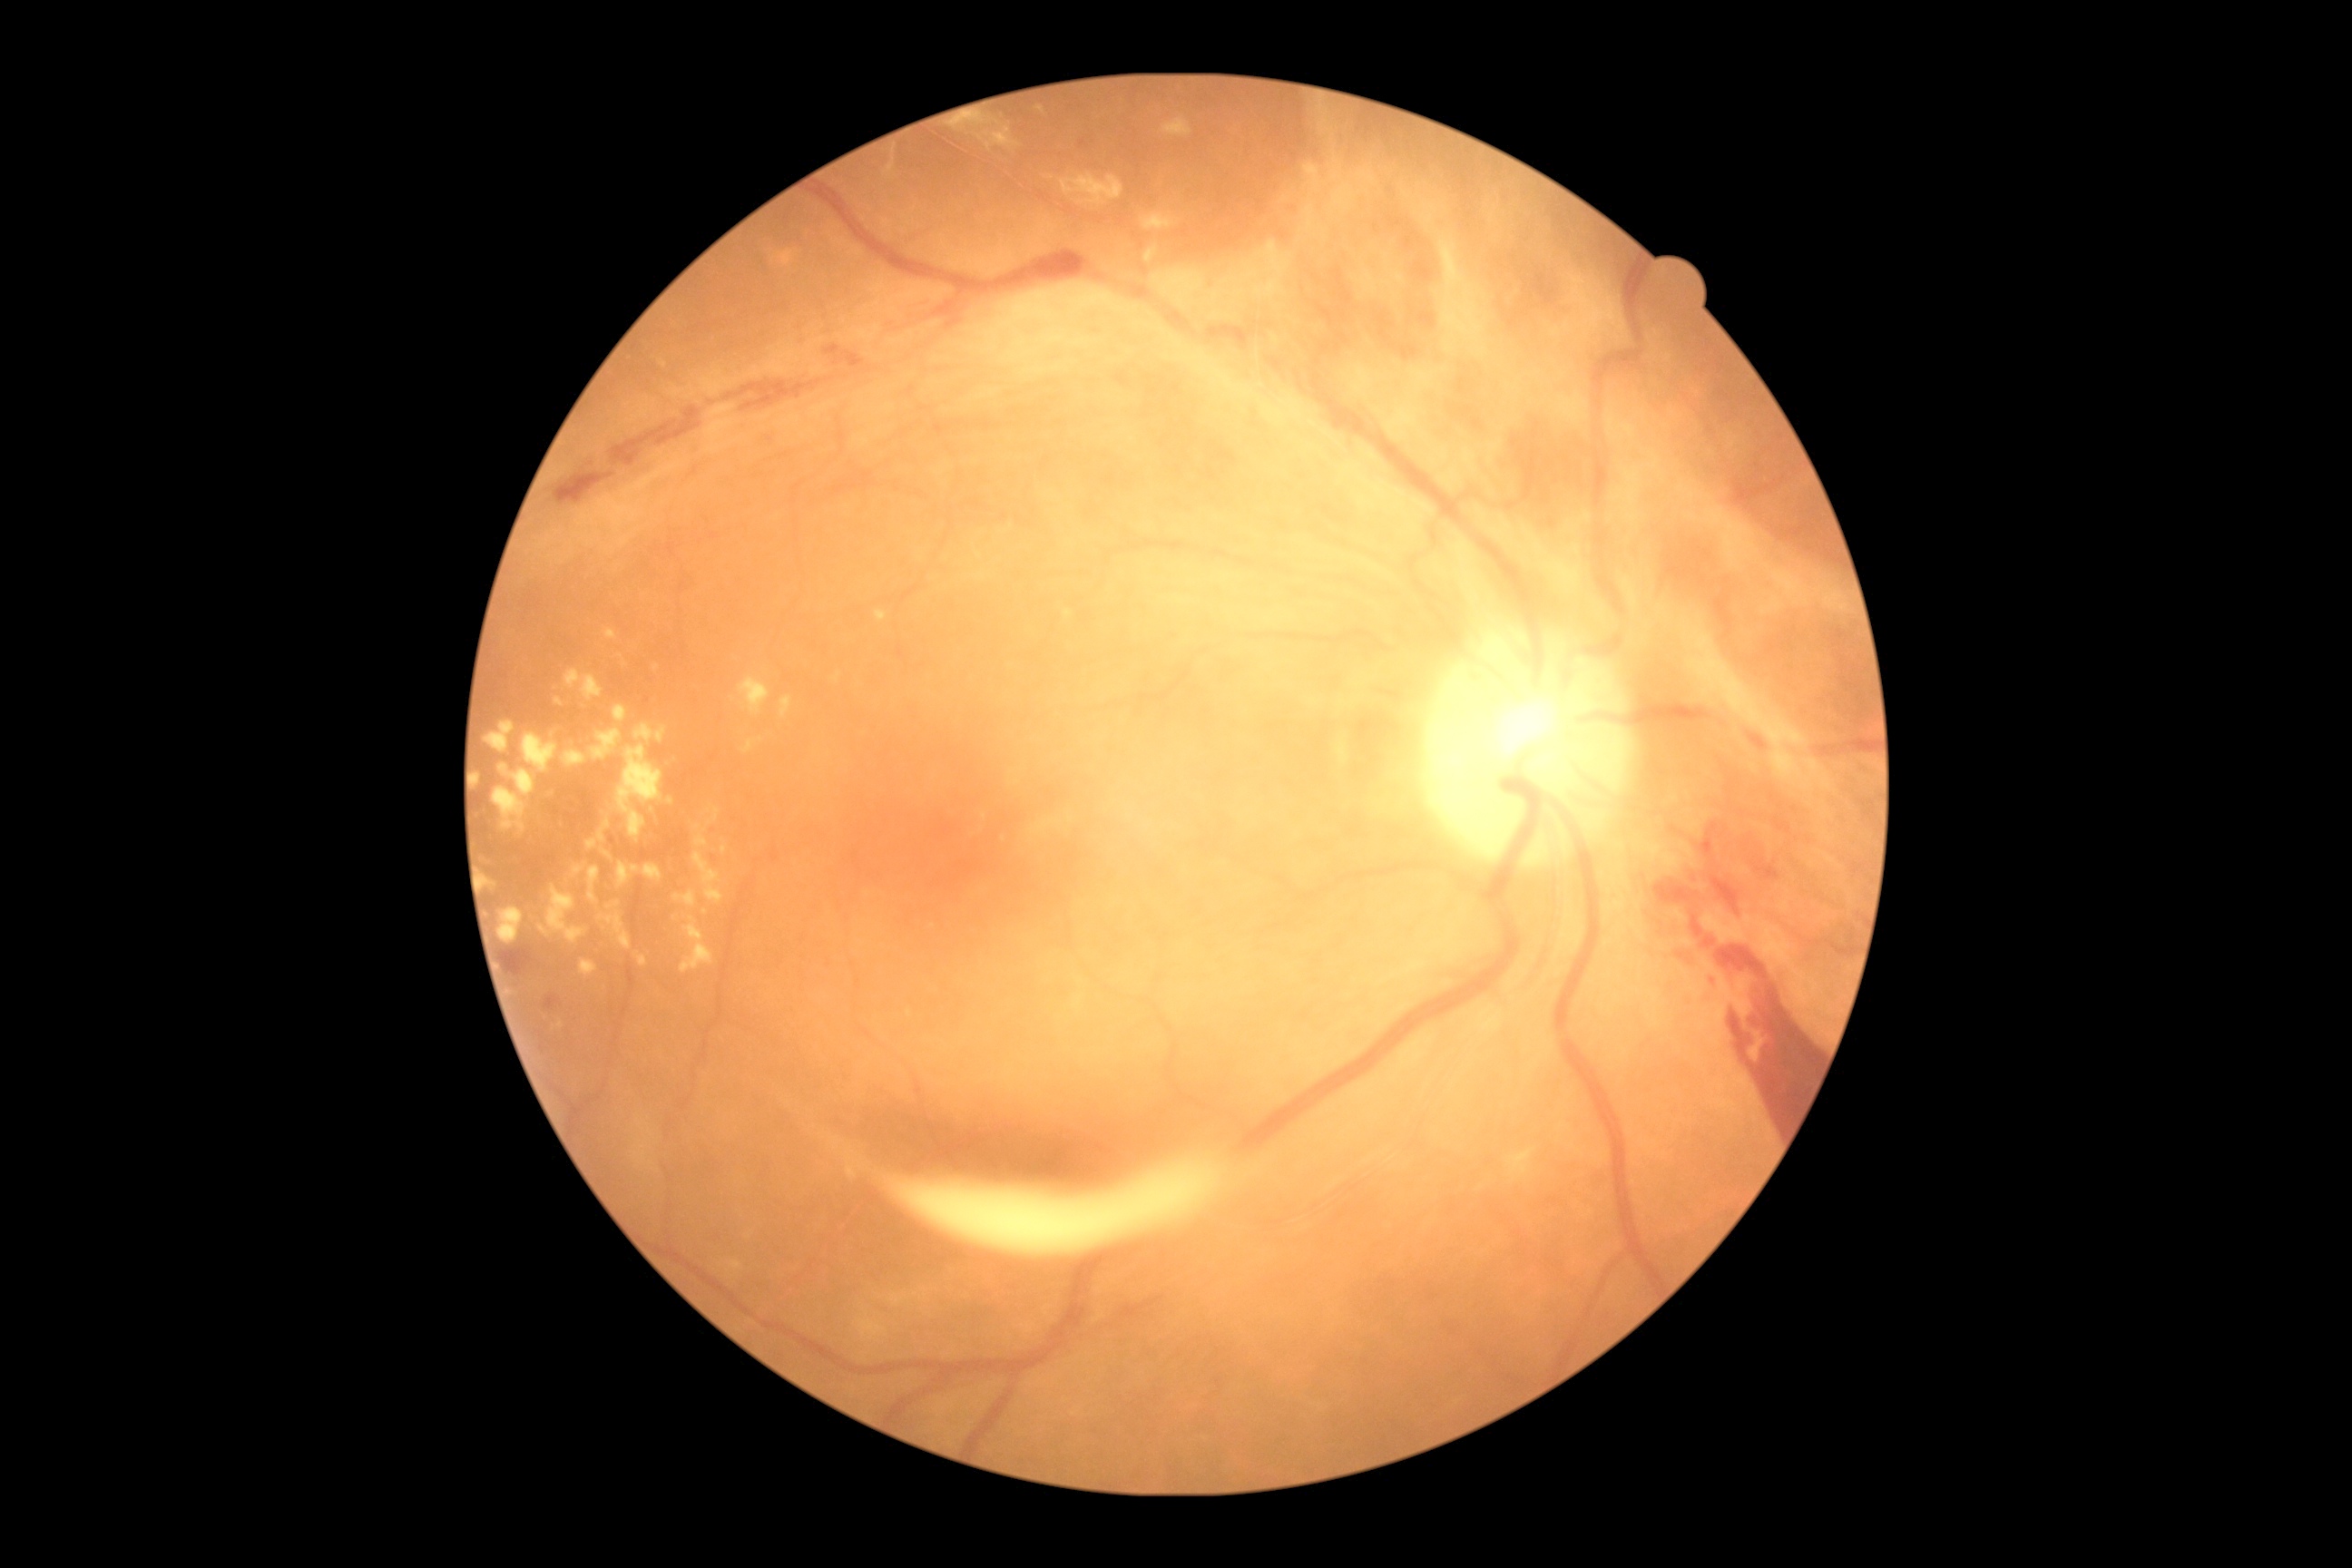

Diabetic retinopathy severity: grade 4; proliferative diabetic retinopathy
Selected lesions:
• hard exudates (continued): 843,1148,867,1181; 593,729,623,761; 565,671,582,691; 554,698,564,707; 600,912,632,950; 1162,119,1193,137; 605,631,618,640; 977,574,985,580; 1458,266,1476,293; 778,251,794,268; 696,834,707,847; 681,917,714,974; 600,848,614,861
• Small hard exudates near Point(657, 668); Point(698, 827); Point(1004, 839); Point(774, 259)